DR severity per modified Davis staging; fundus photo: 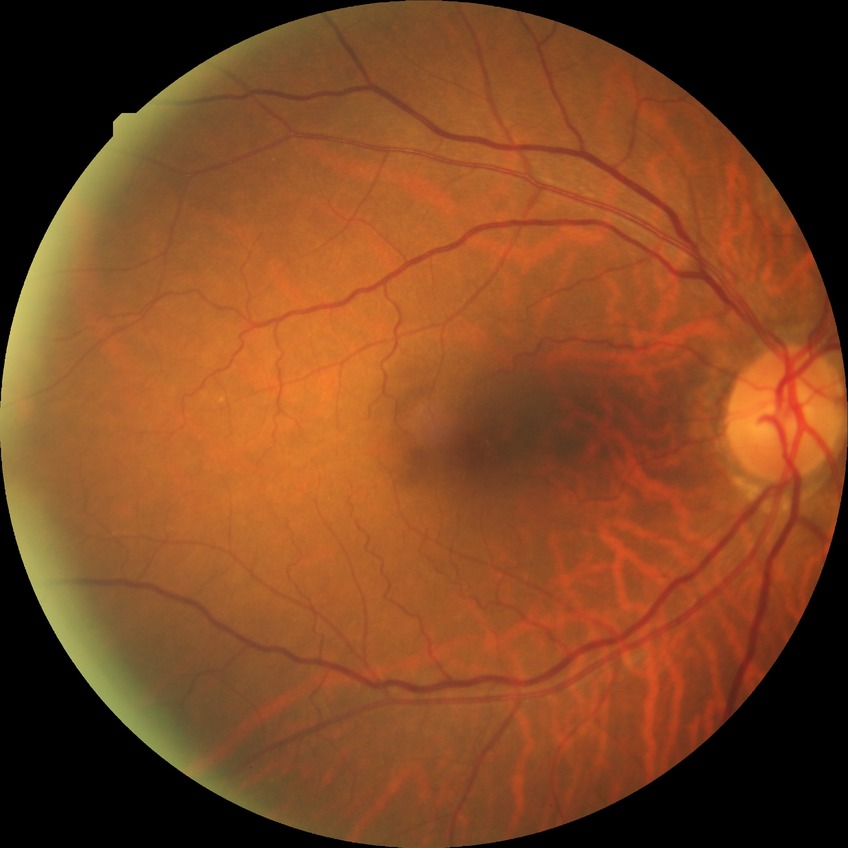

– DR stage — NDR